Without pupil dilation
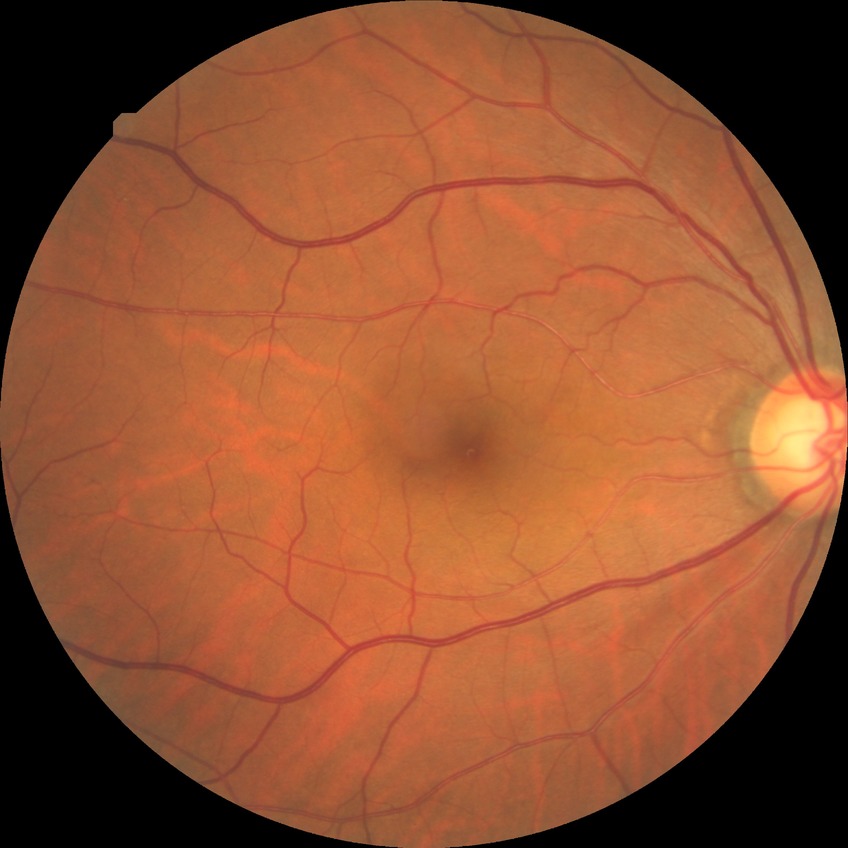 diabetic retinopathy (DR): no diabetic retinopathy (NDR)